2352 x 1568 pixels, 45-degree field of view — 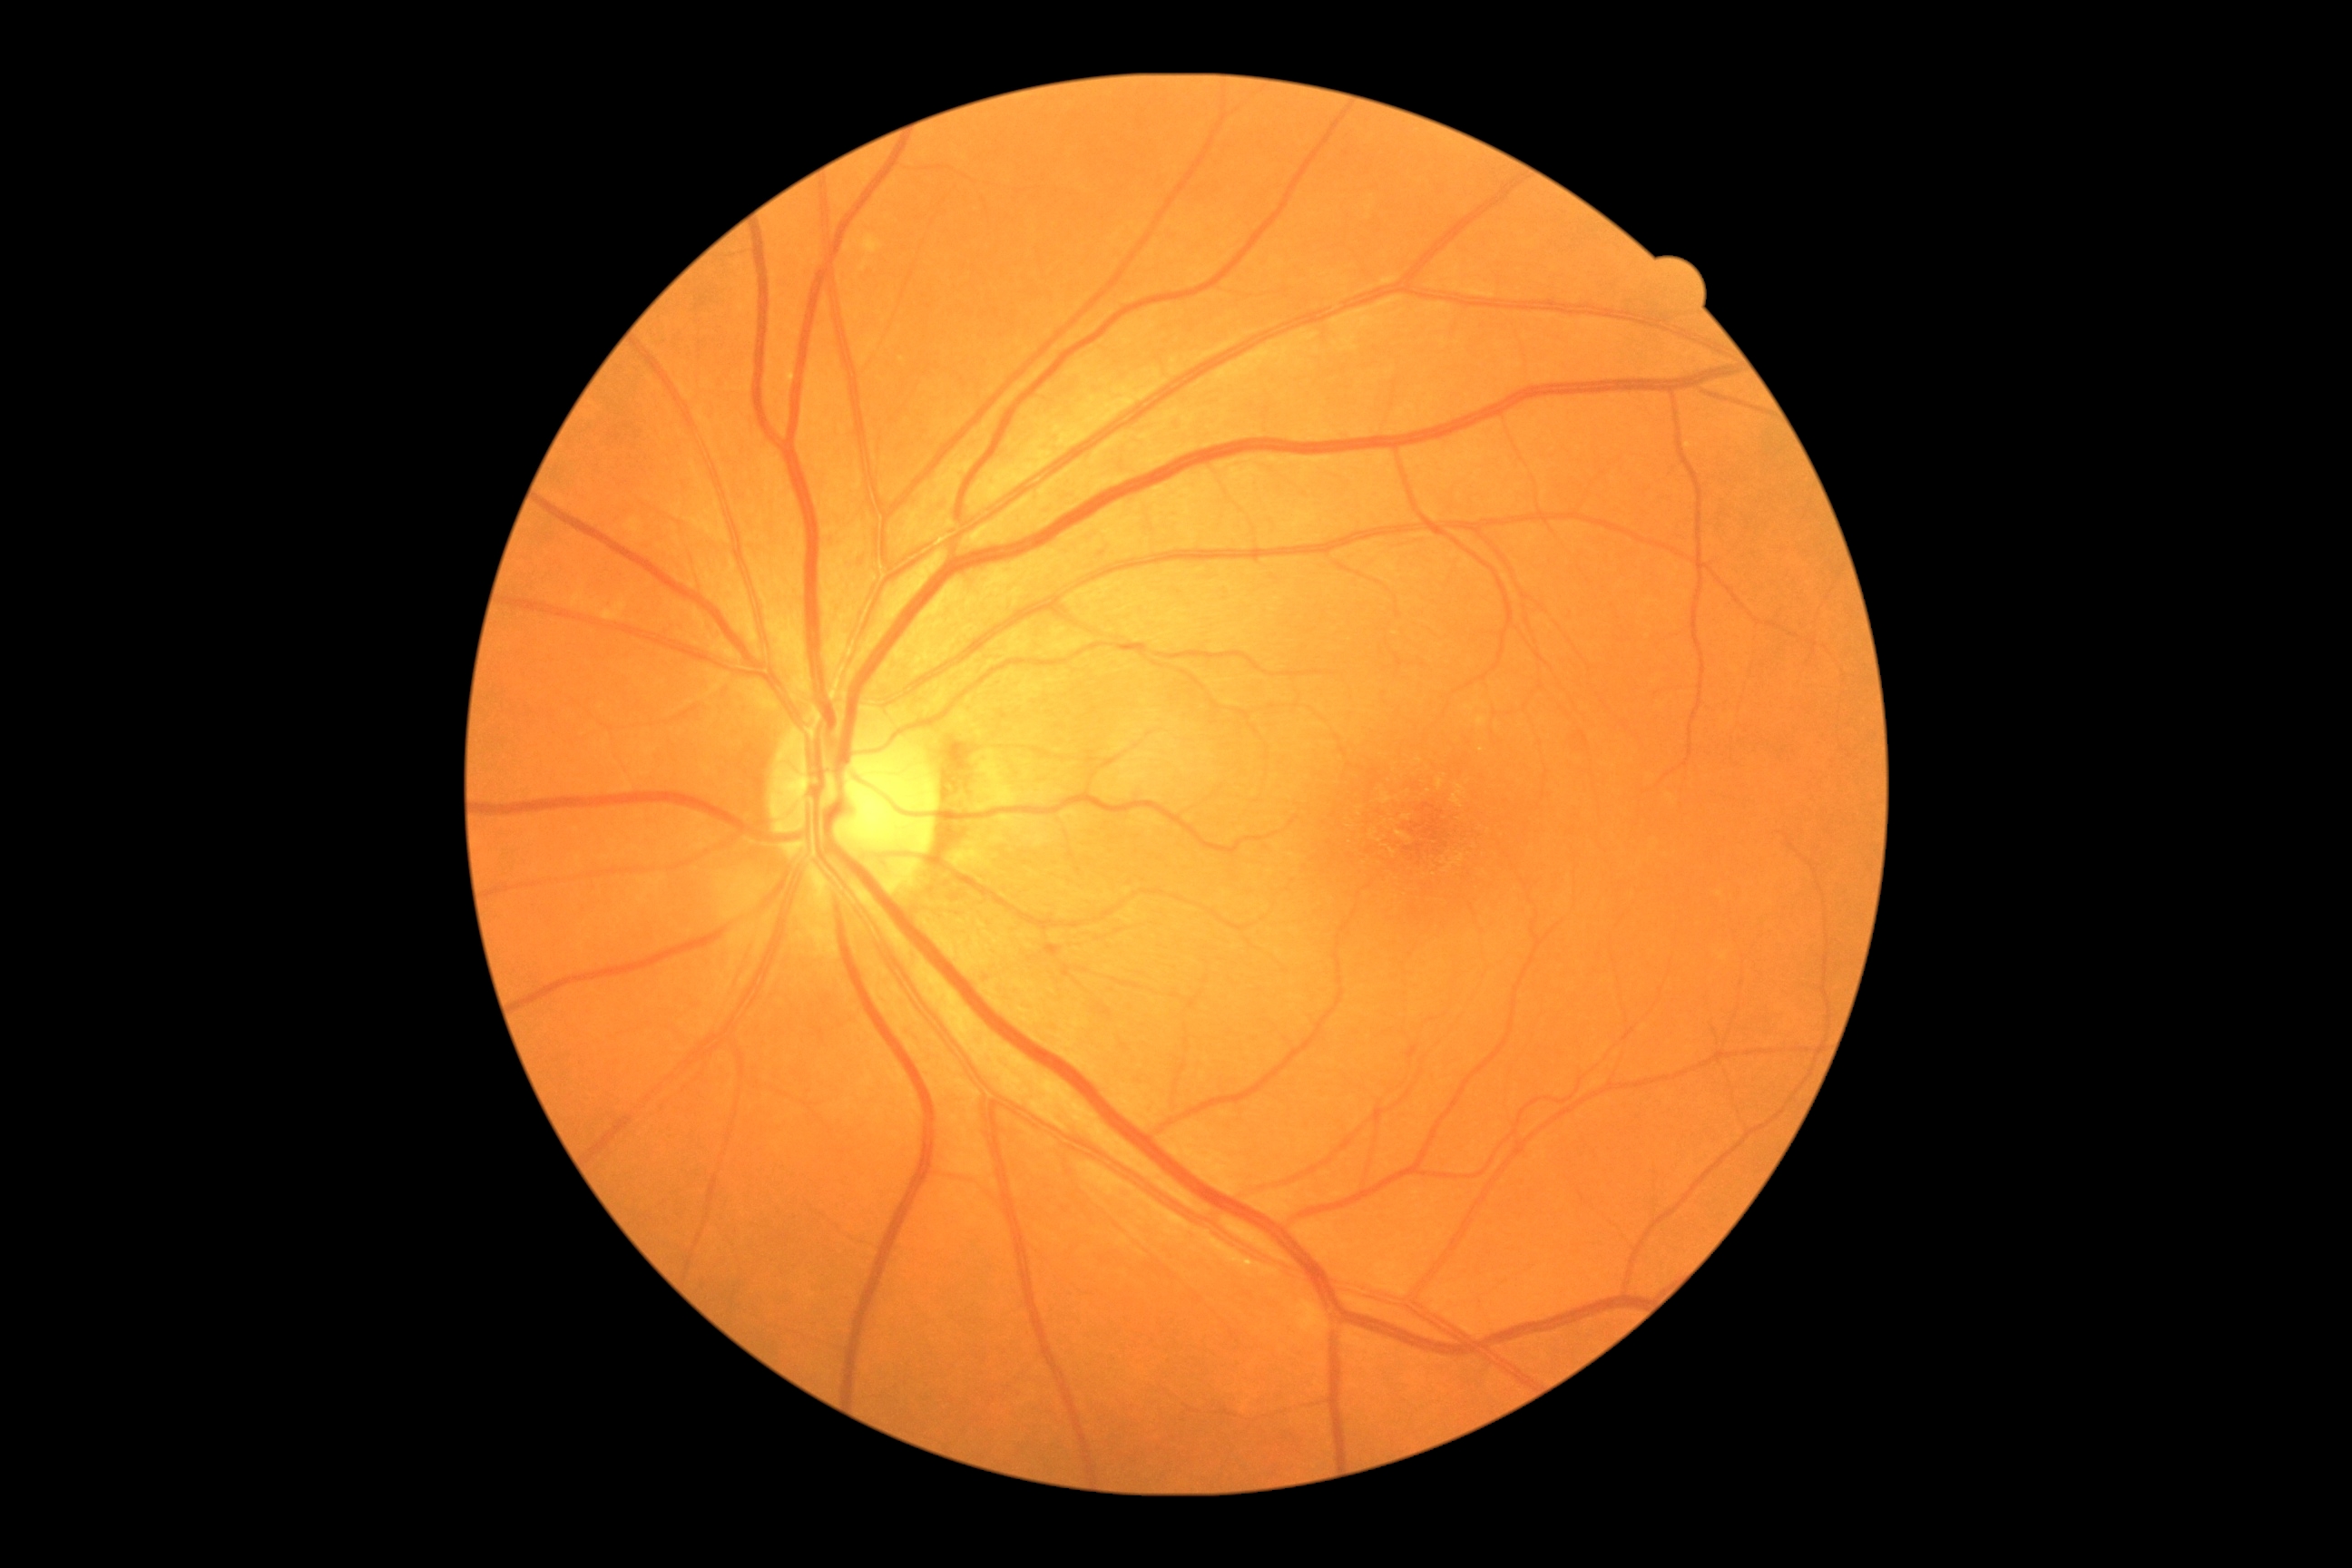

DR grade is 0/4 — no visible signs of diabetic retinopathy.